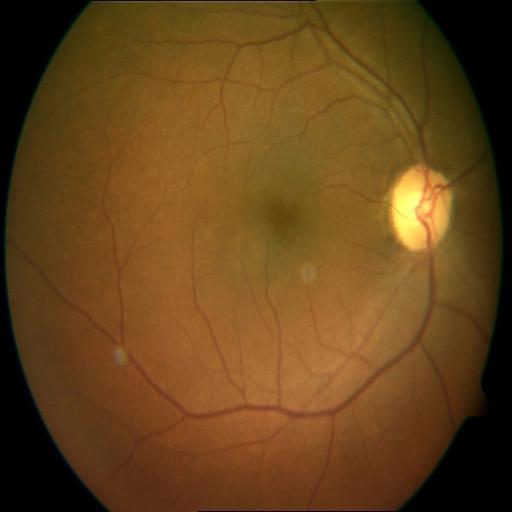 No abnormal findings on fundus examination.